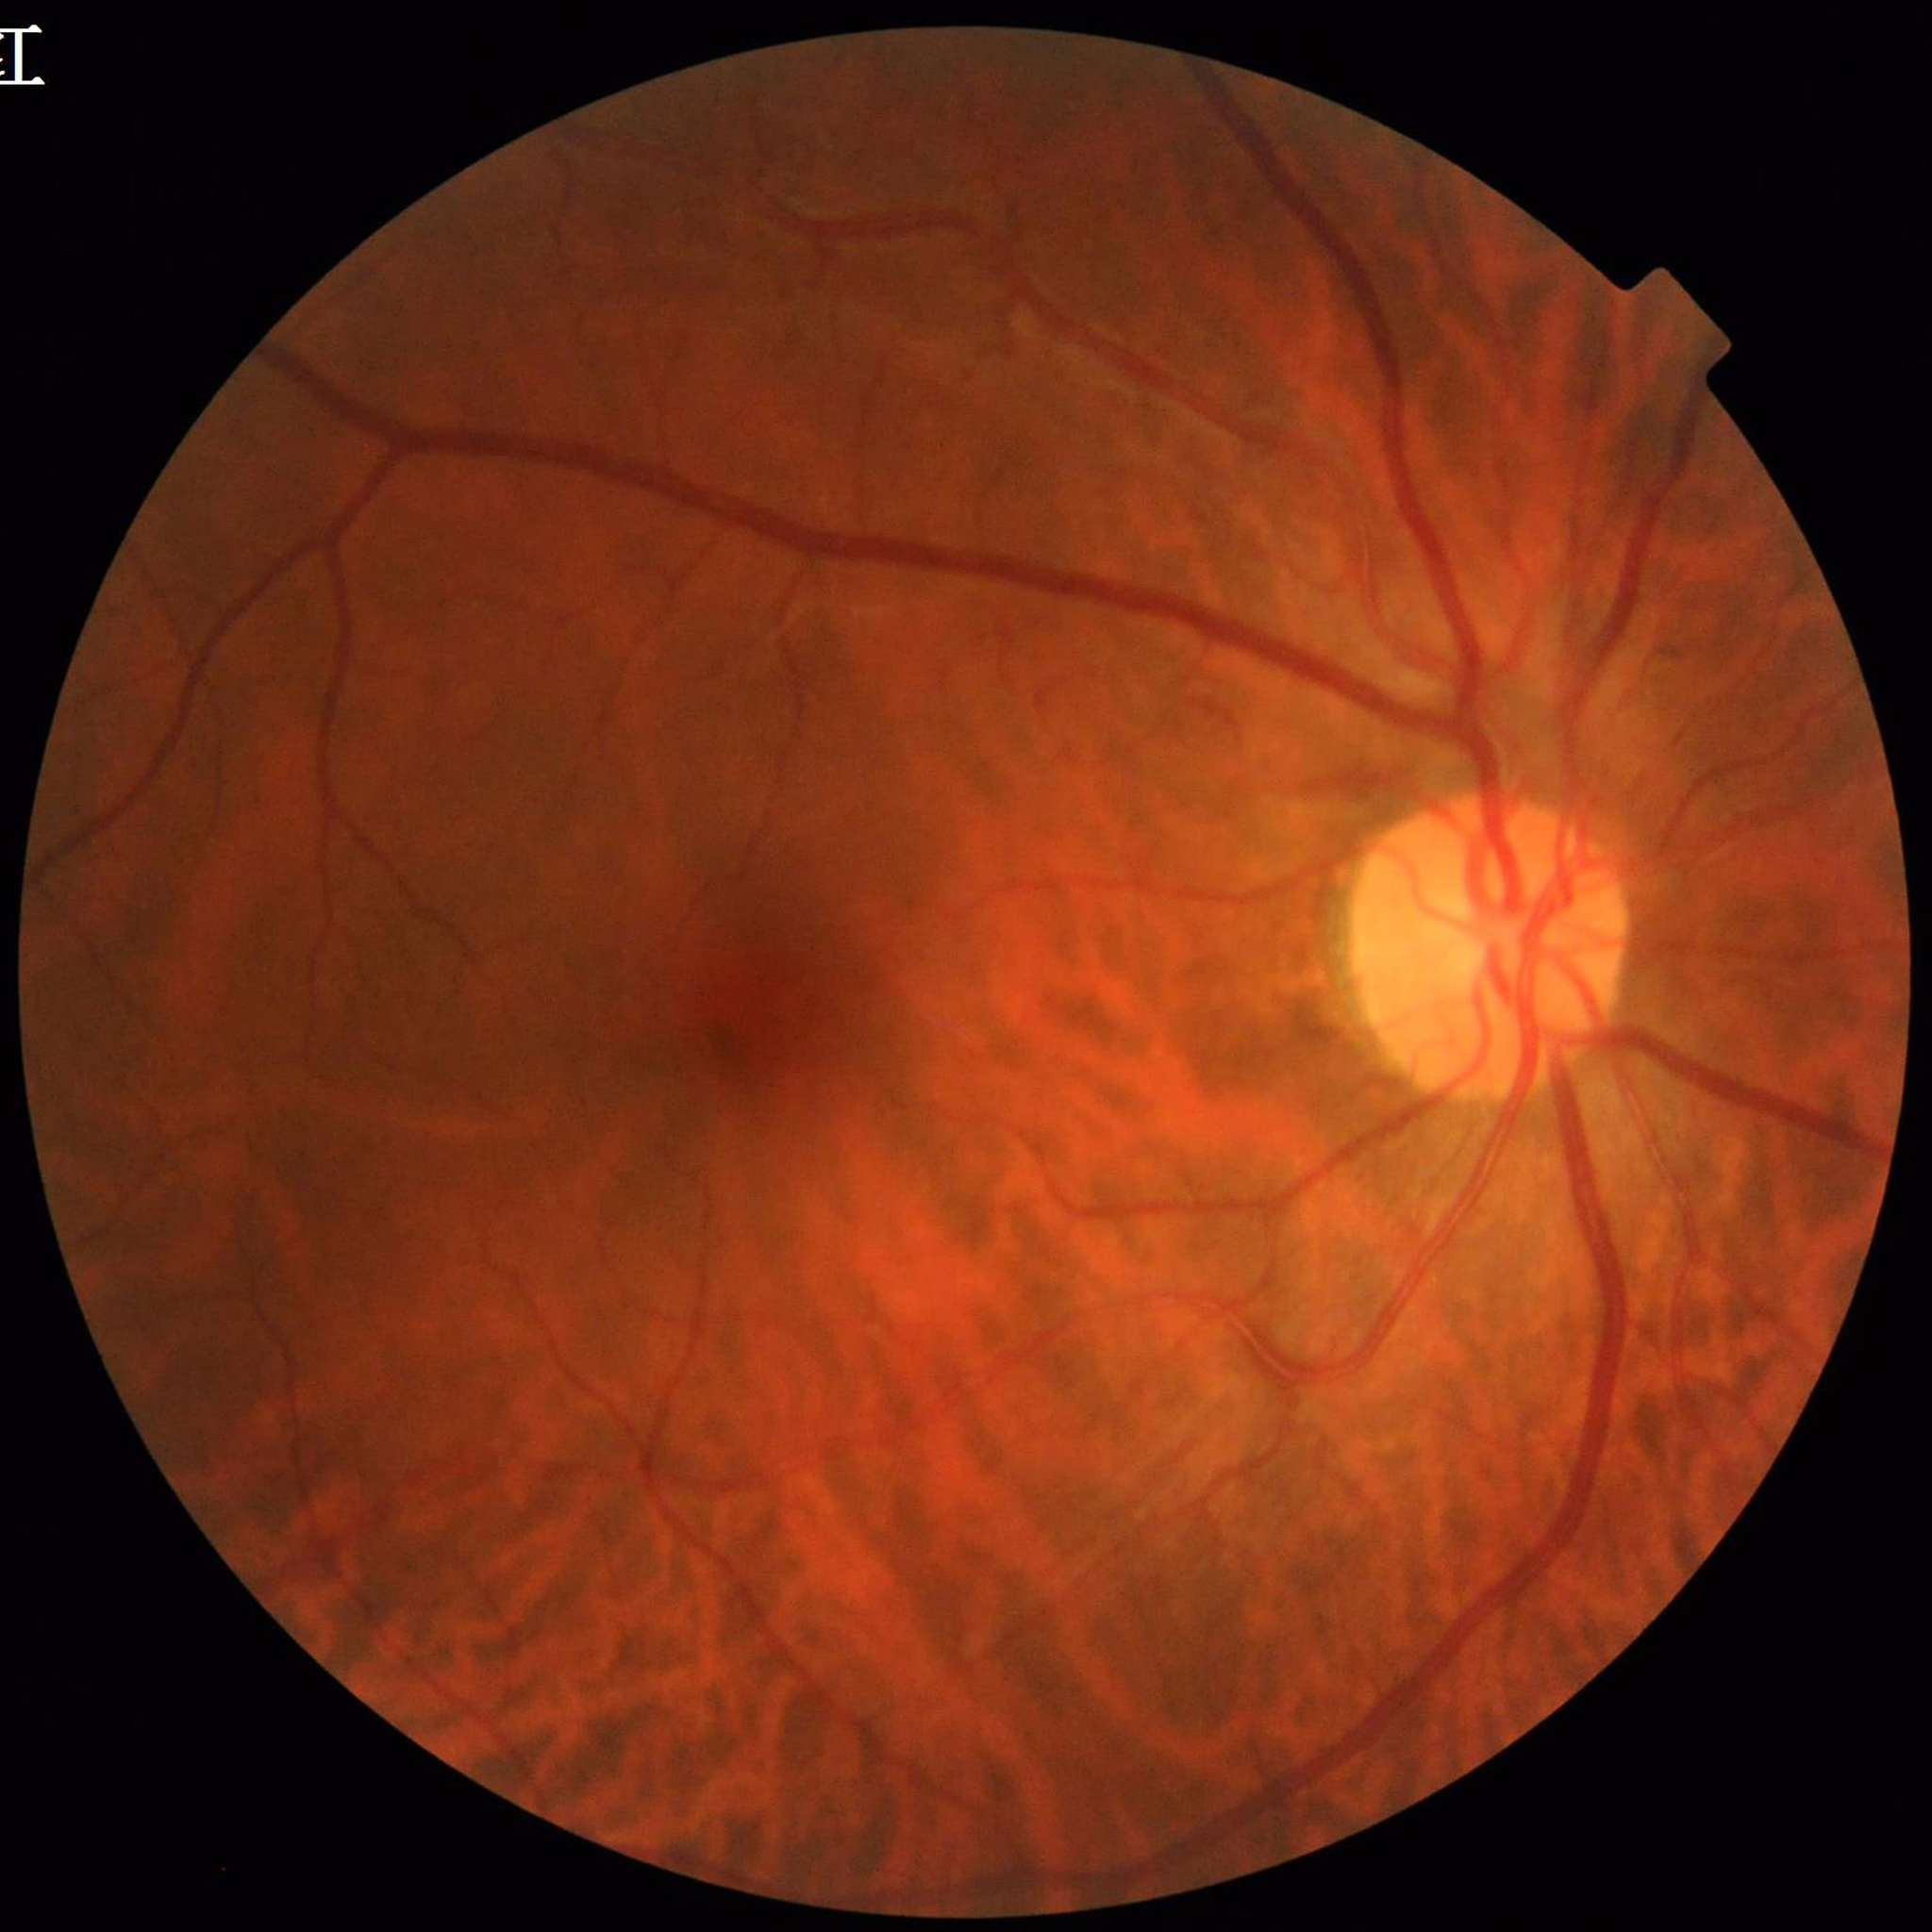 Quality assessment: no concerns identified. This fundus photograph is from a patient diagnosed with diabetic retinopathy (DR).